848x848, modified Davis grading:
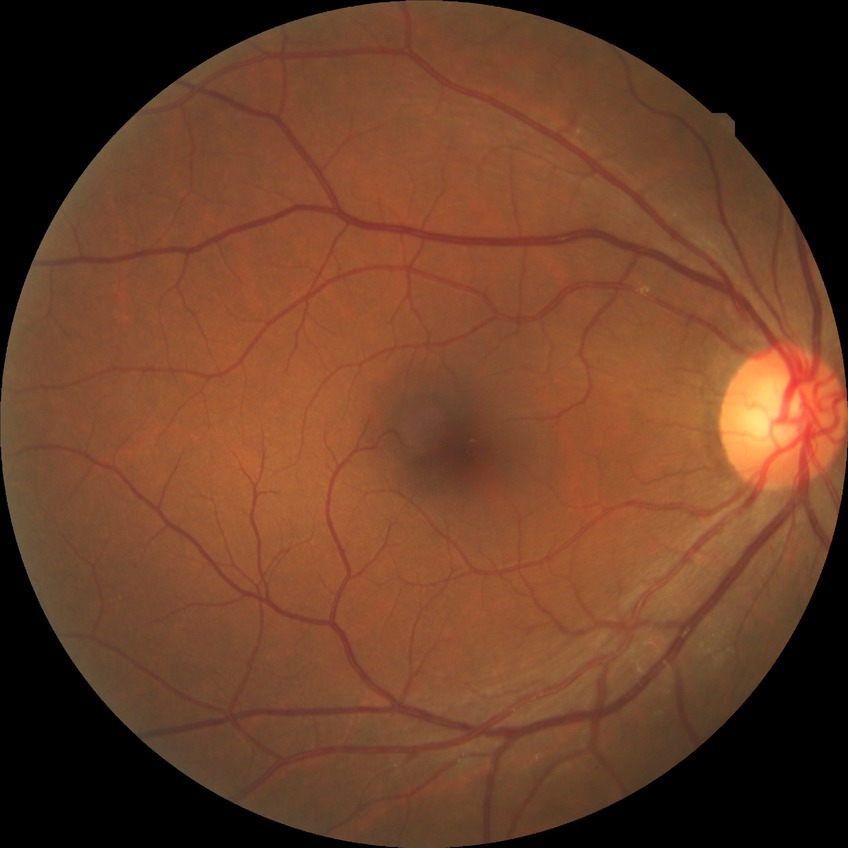
Diabetic retinopathy (DR): no diabetic retinopathy (NDR).